Infant wide-field fundus photograph:
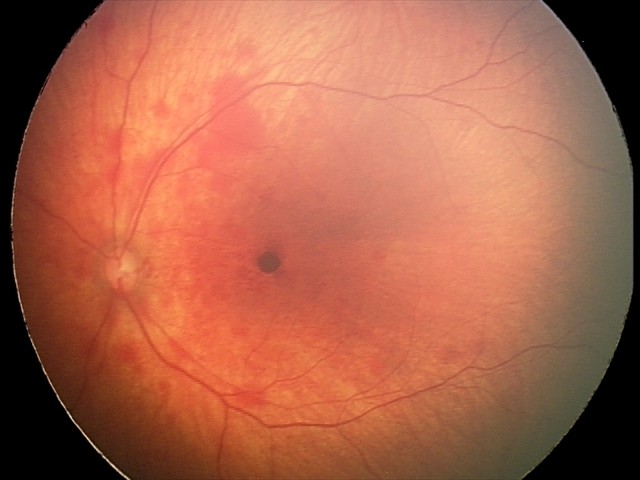 Series diagnosed as retinal hemorrhages.